Pediatric wide-field fundus photograph:
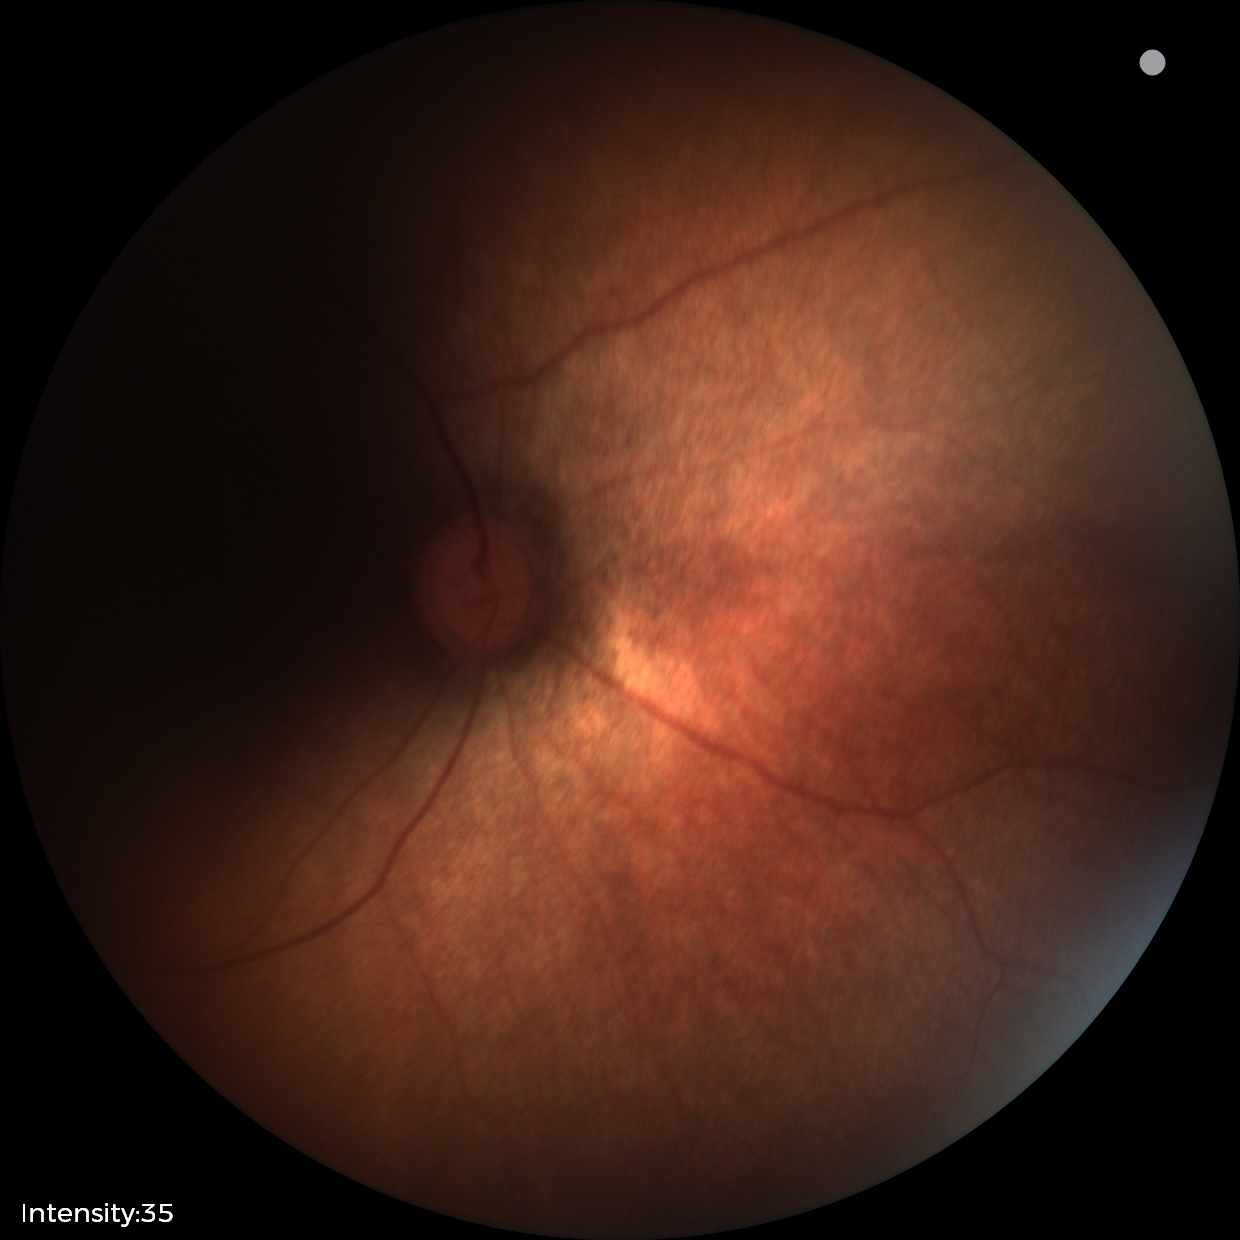
Q: What is the screening diagnosis?
A: physiological finding